1240x1240 · infant wide-field fundus photograph
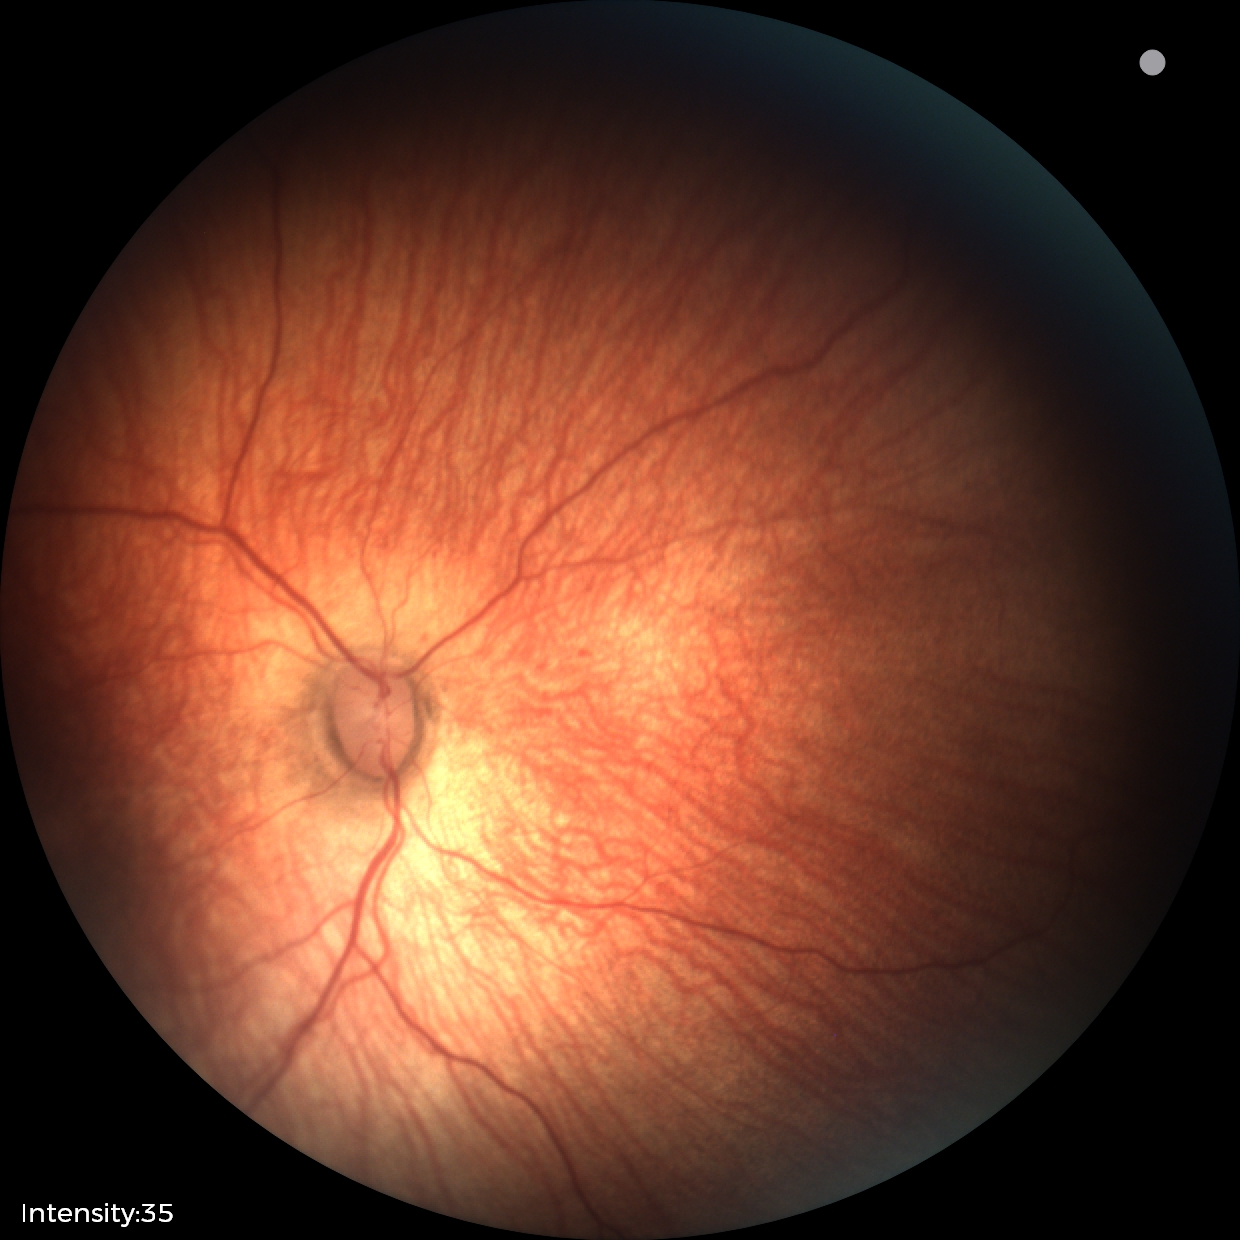 Examination diagnosed as status post ROP — retinal appearance after treated retinopathy of prematurity.